DR severity per modified Davis staging
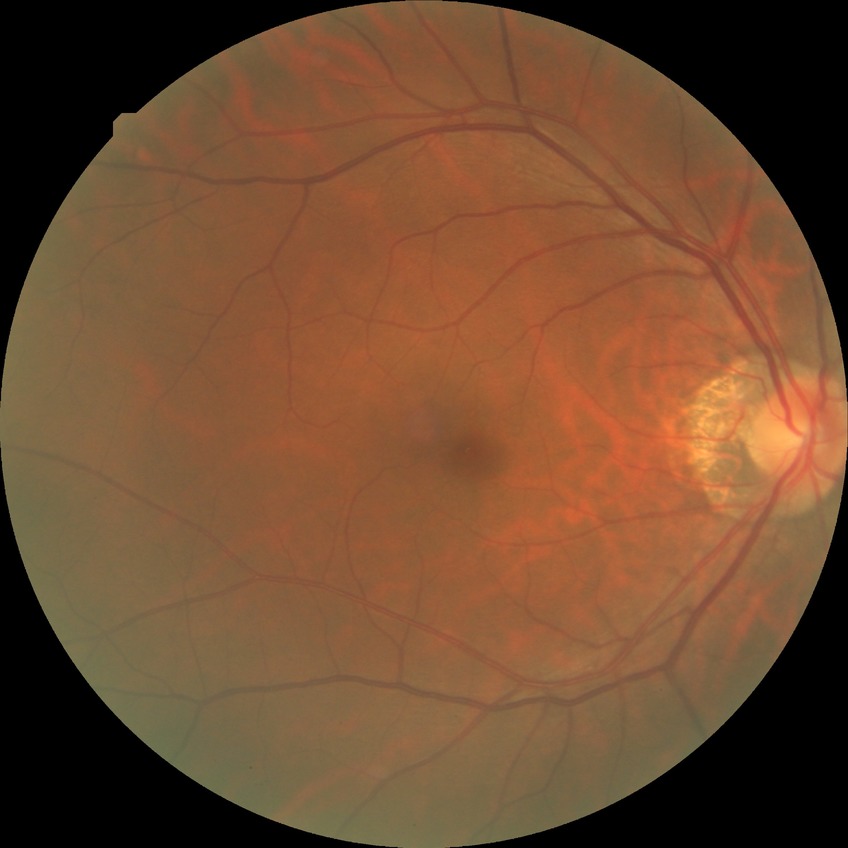 Retinopathy grade is no diabetic retinopathy.